45° FOV, CFP, NIDEK AFC-230, nonmydriatic fundus photograph — 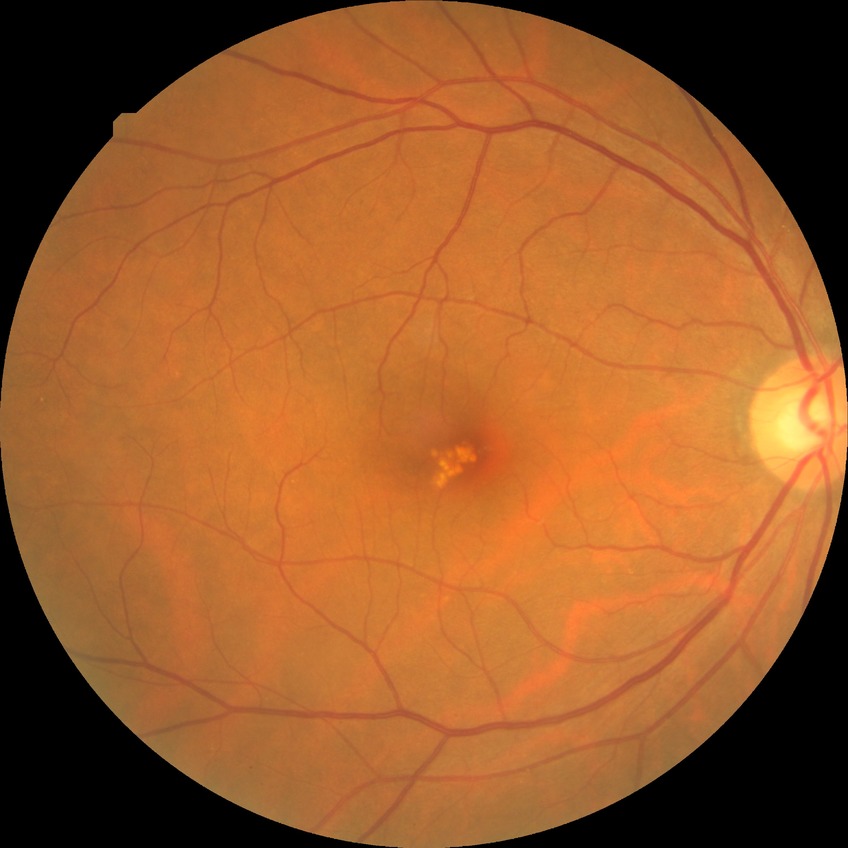
Diabetic retinopathy (DR) is NDR (no diabetic retinopathy).